Retinal fundus photograph · 2352x1568px · 45-degree field of view — 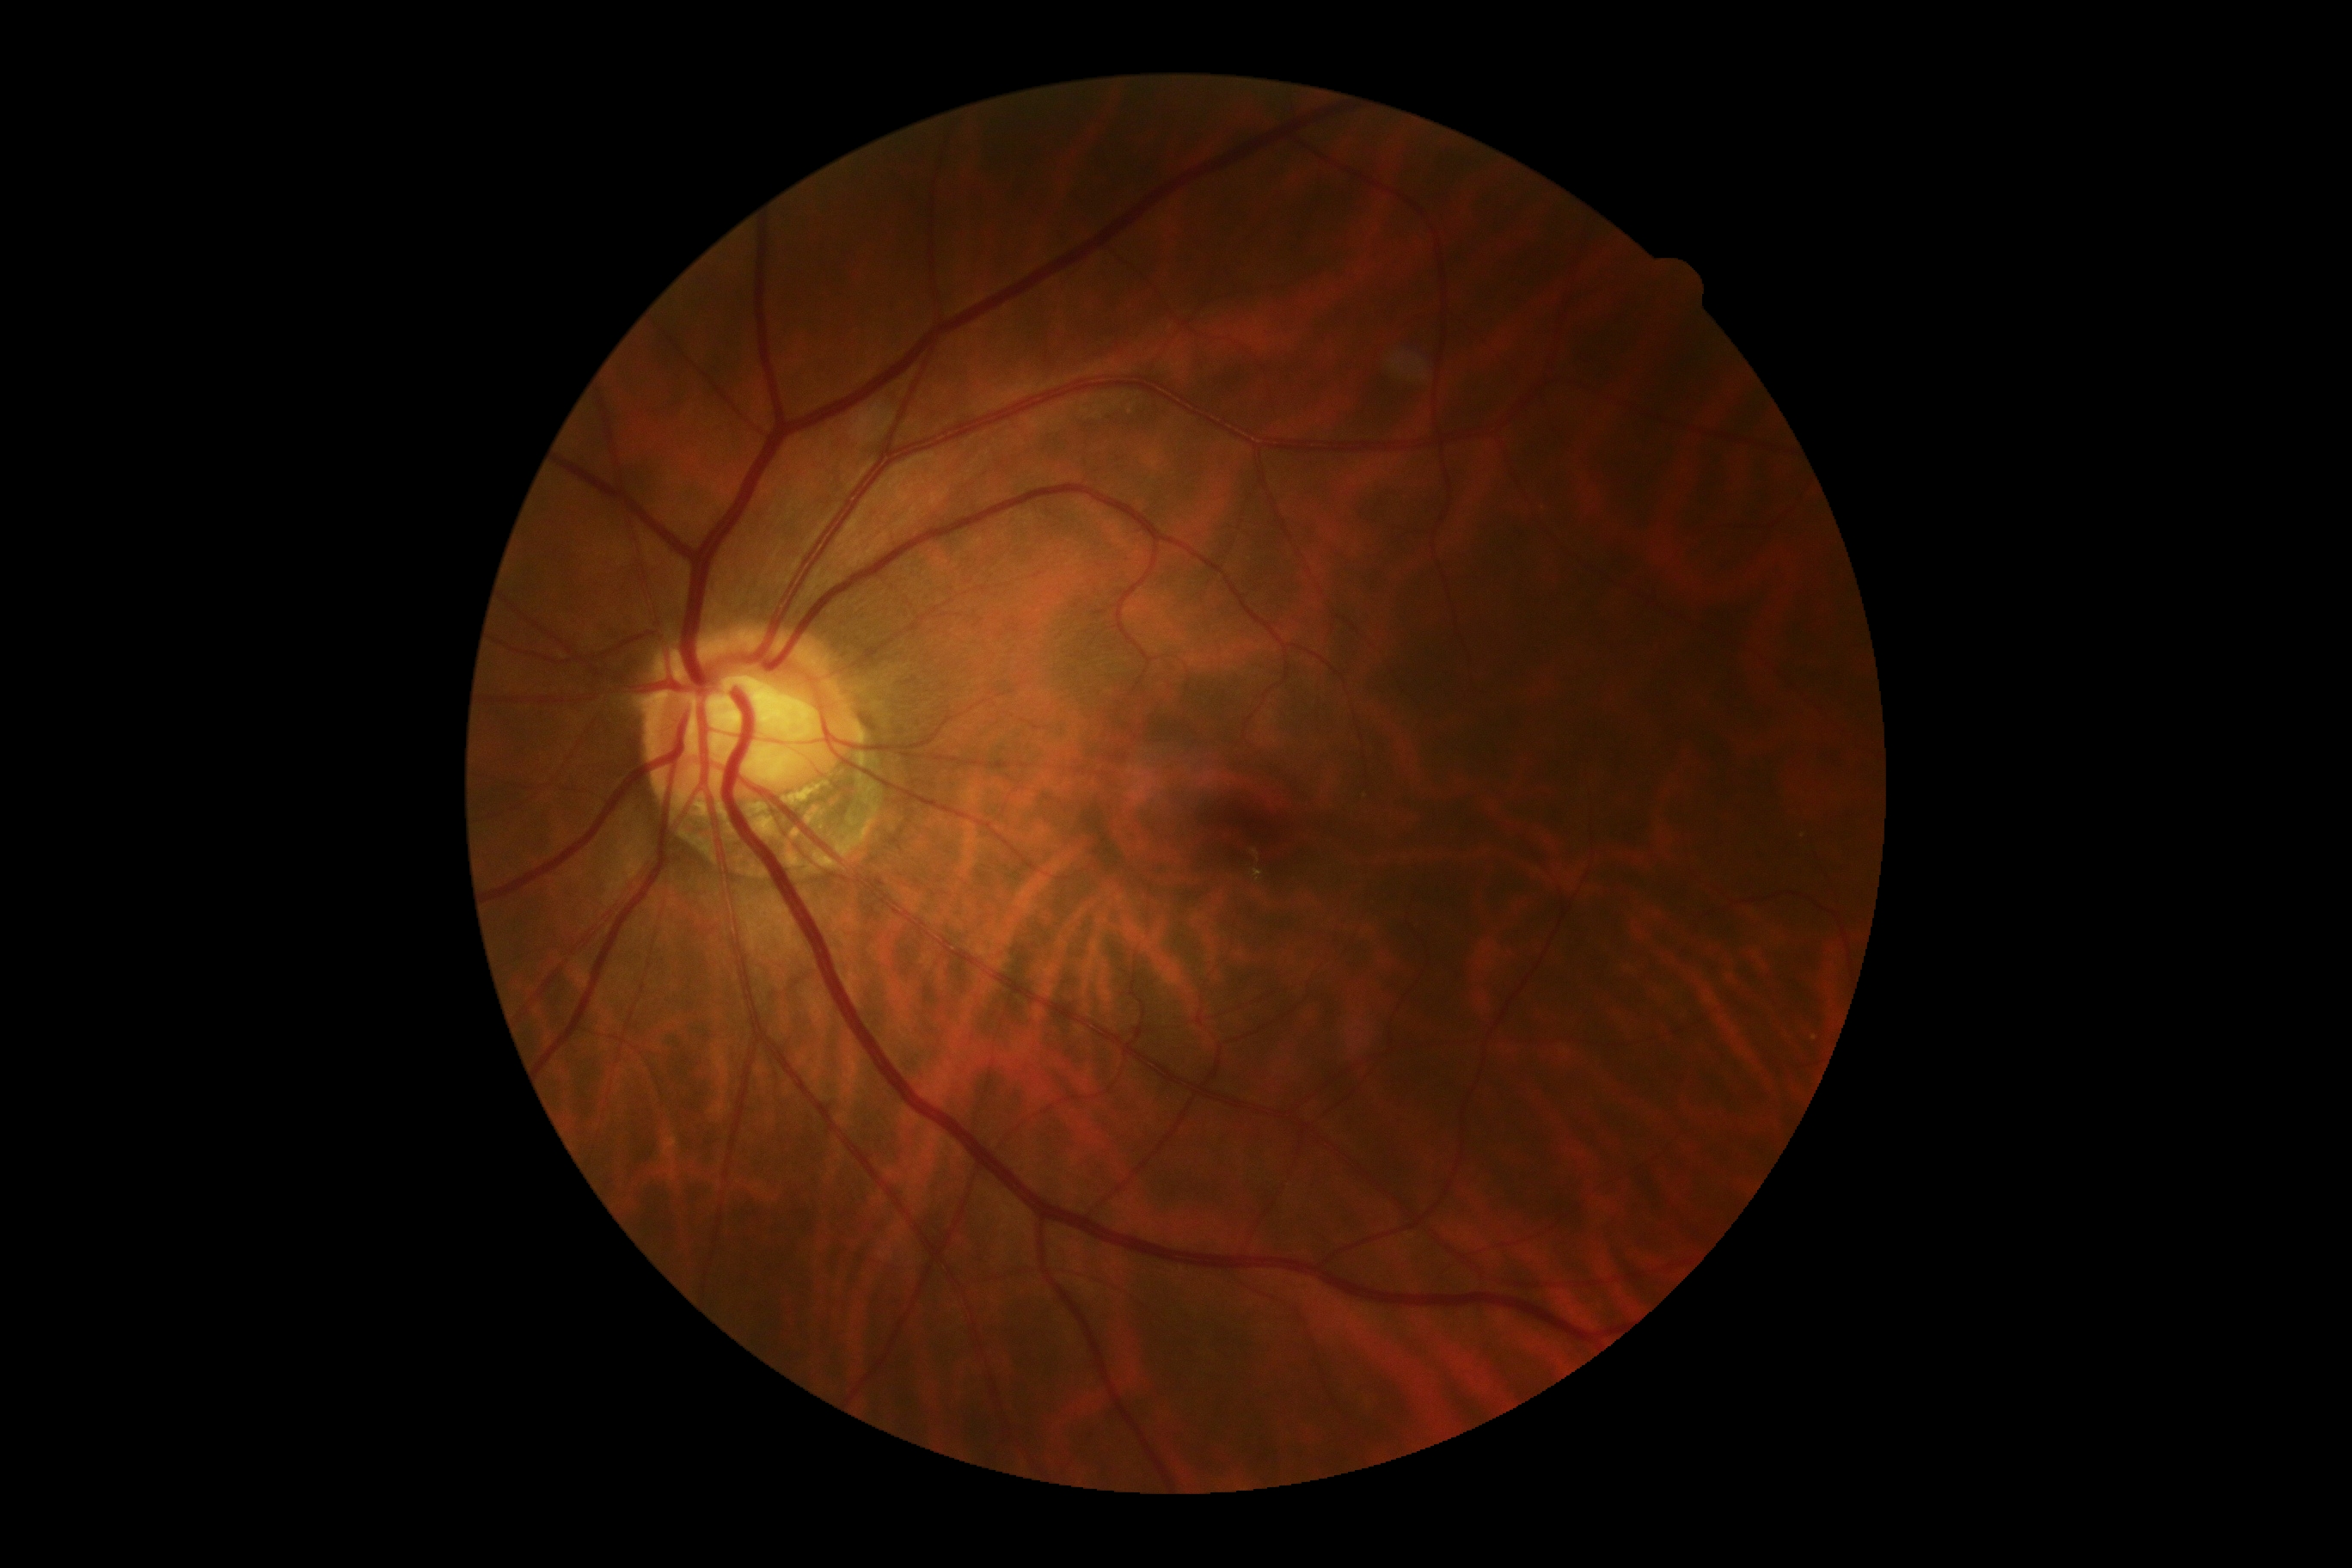

Diabetic retinopathy grade is 0.
No diabetic retinal disease findings.